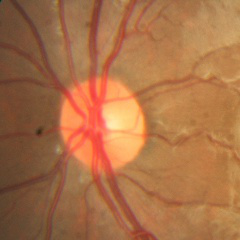
Glaucoma diagnosis = no glaucomatous changes.